Disc-centered field · color fundus photograph · camera: Nidek AFC-330.
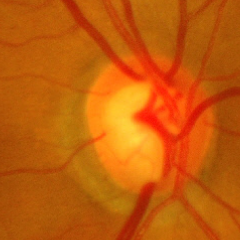 The image shows advanced glaucoma.